FOV: 45 degrees, 2184x1690px: 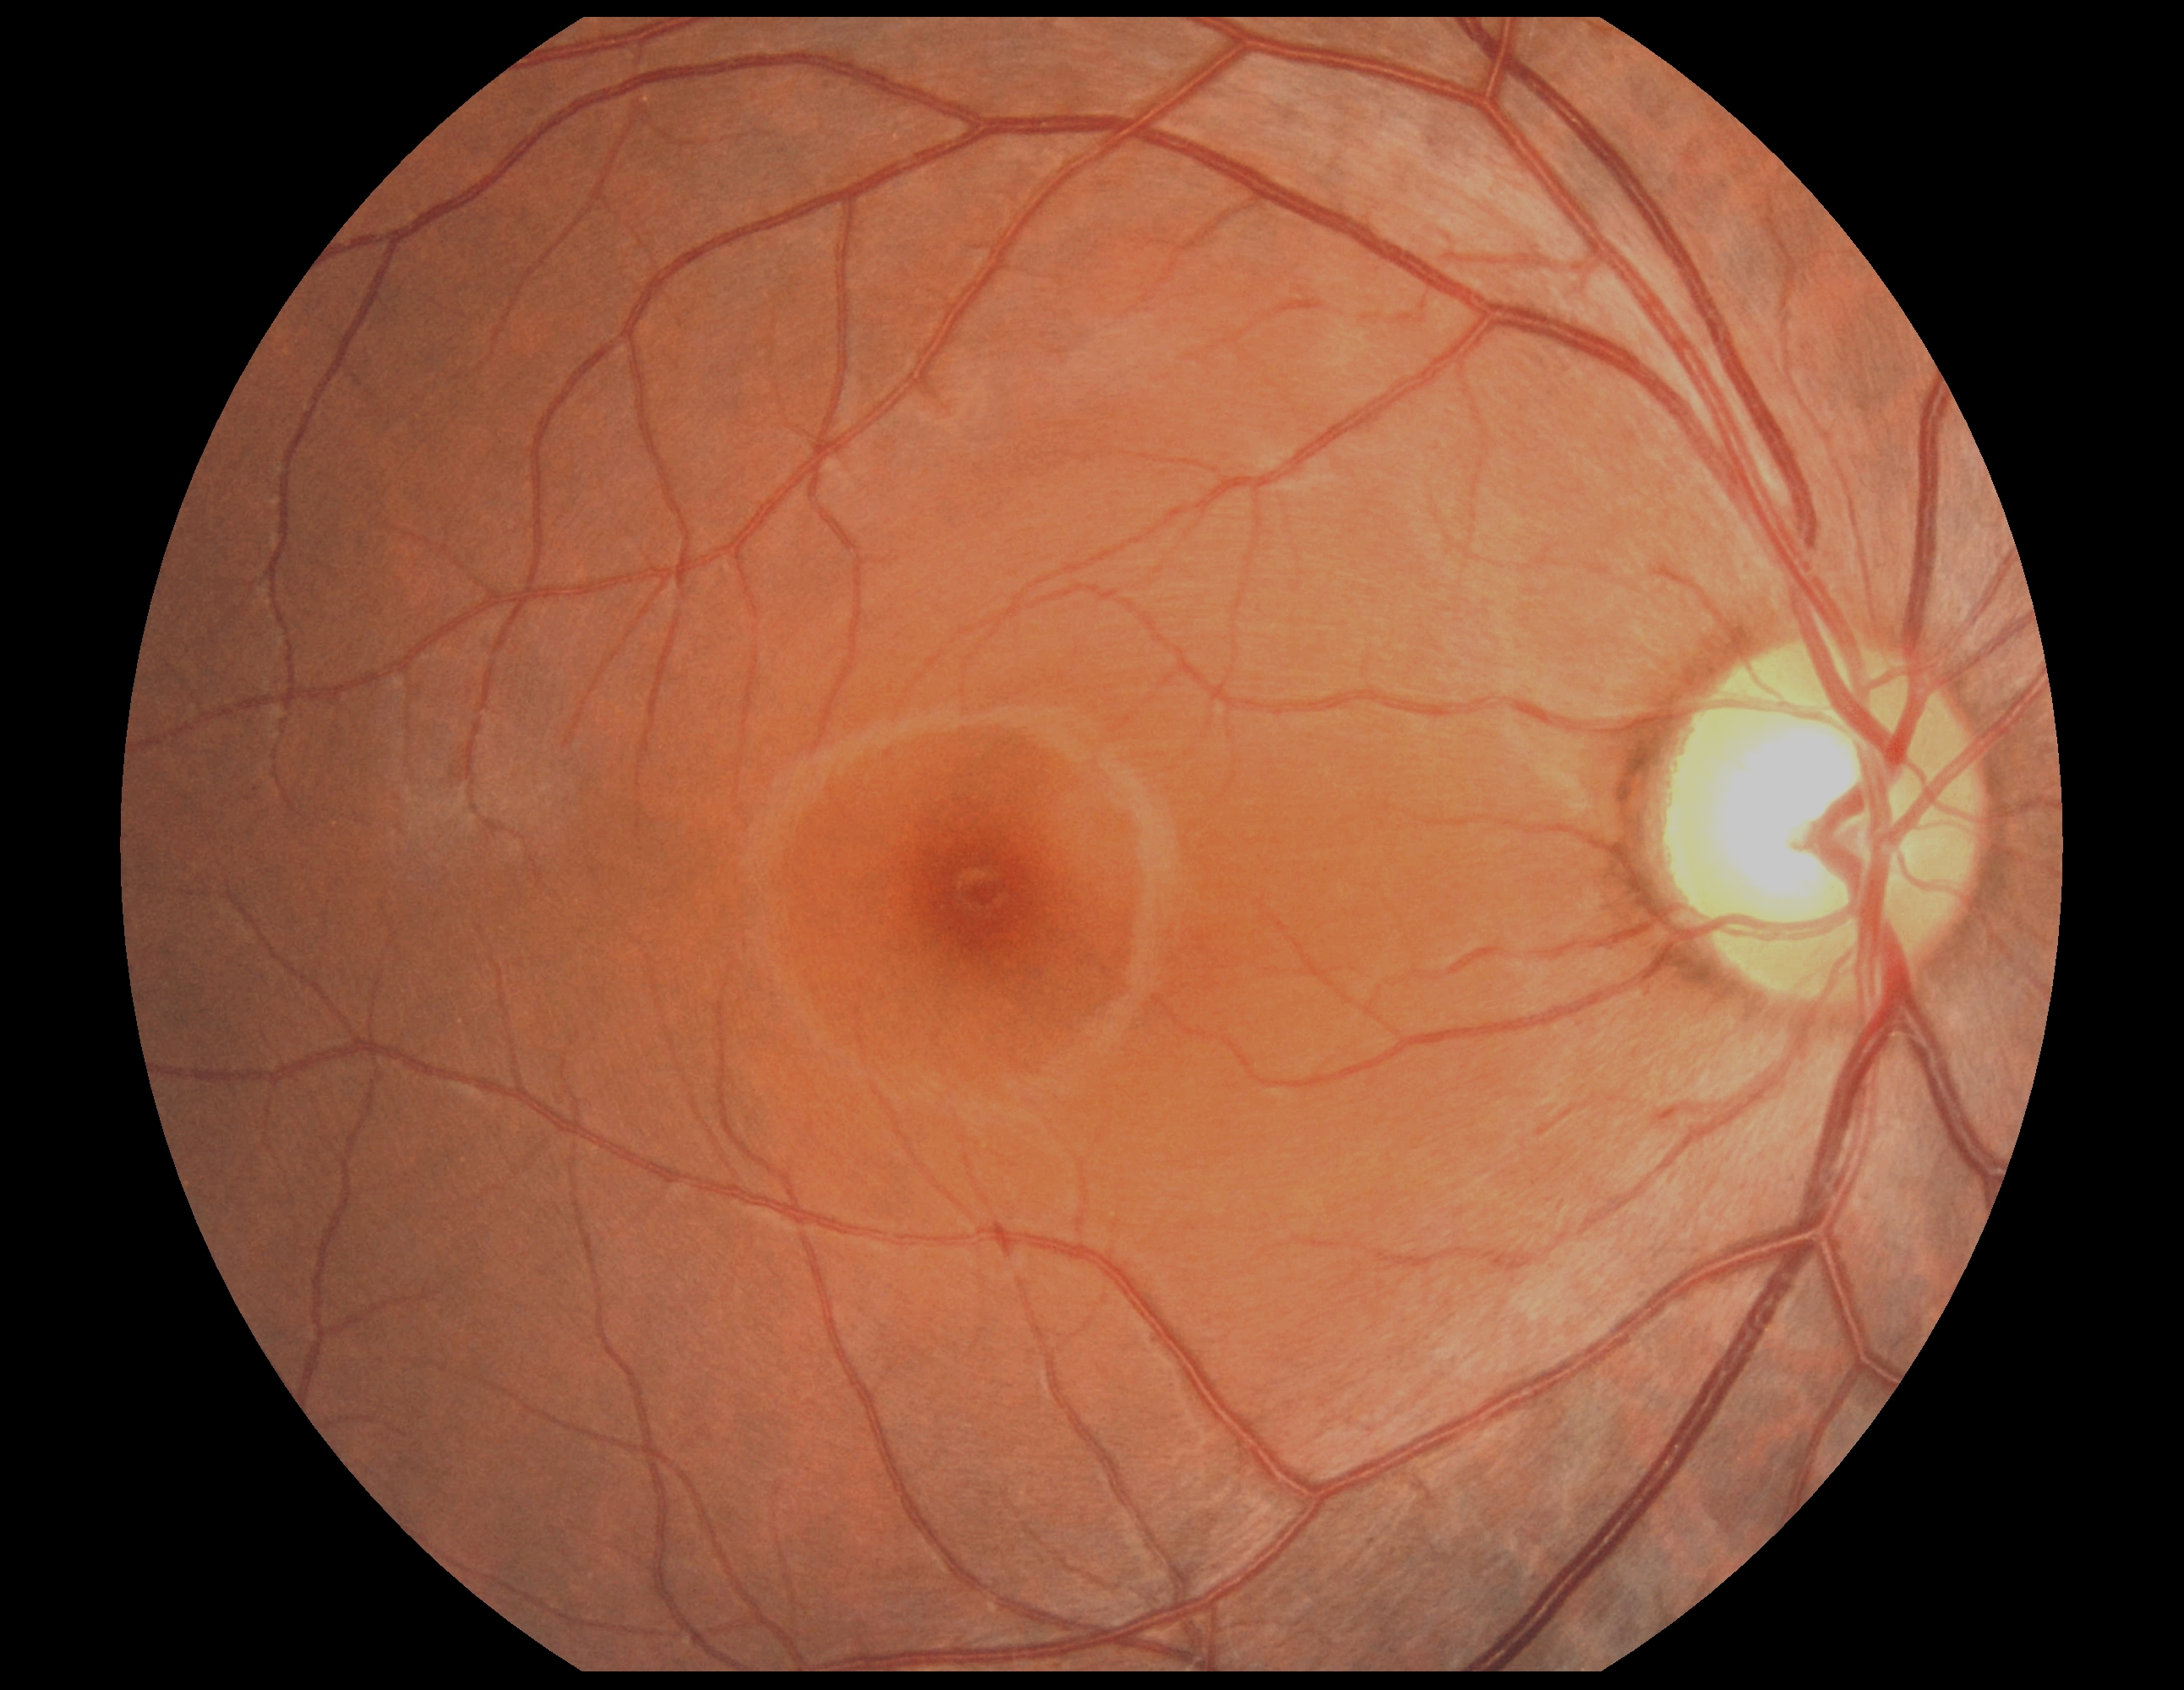

Diabetic retinopathy (DR) is grade 0.